Wide-field fundus image from infant ROP screening. 1440x1080:
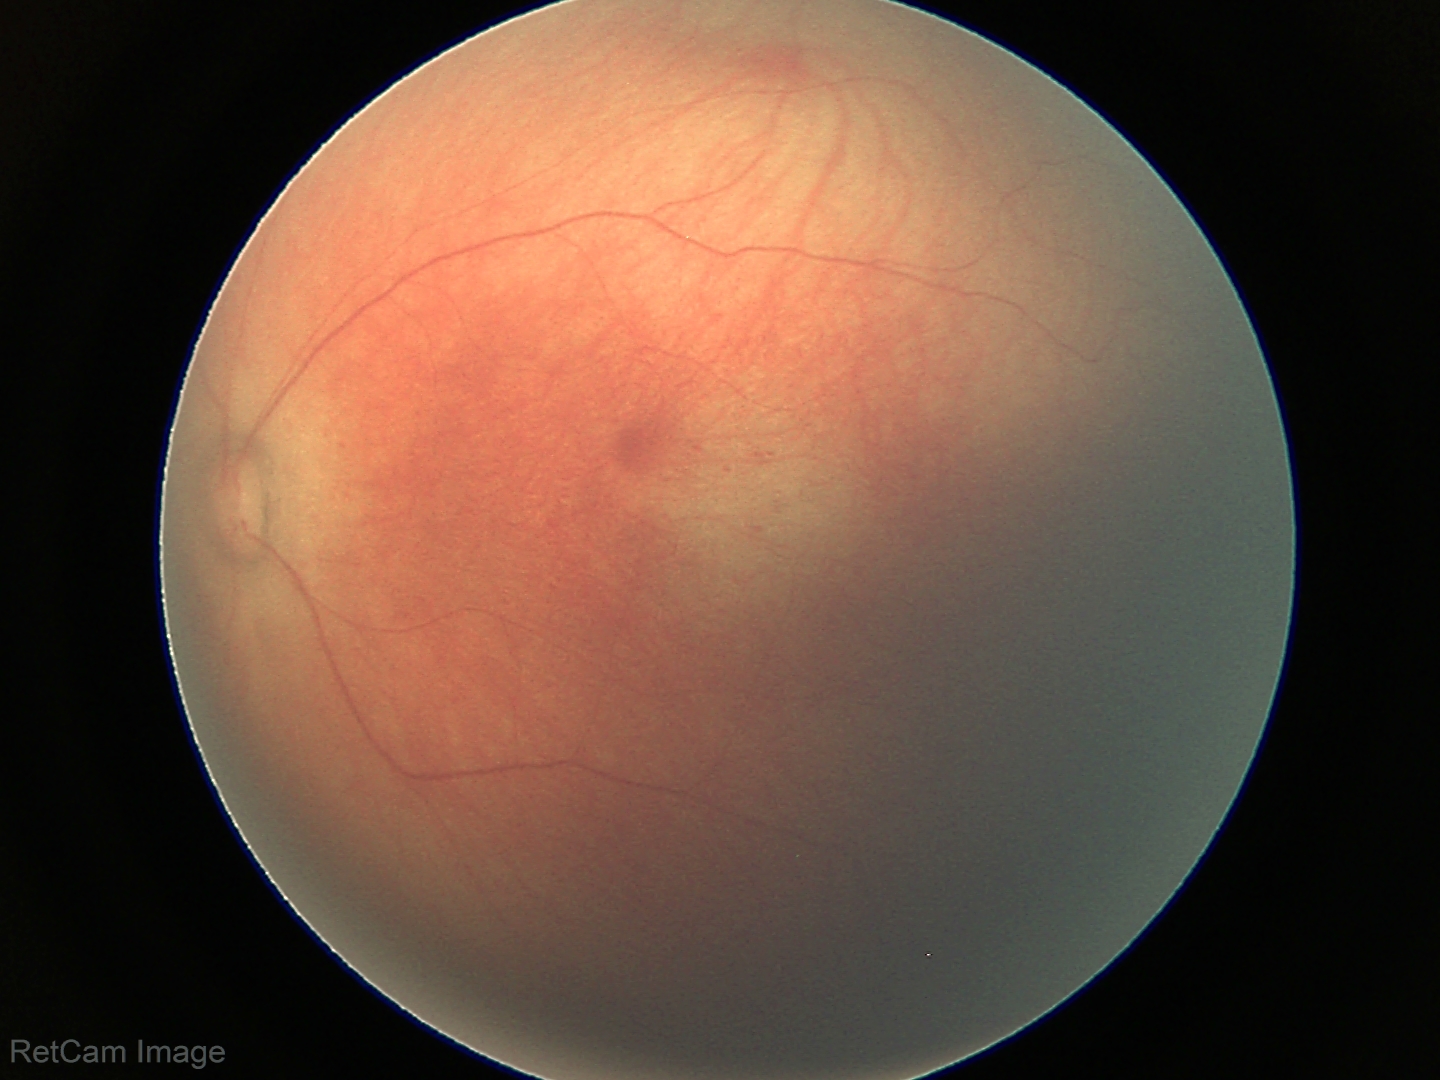 No retinal pathology identified on screening.